640x480px. Wide-field contact fundus photograph of an infant: 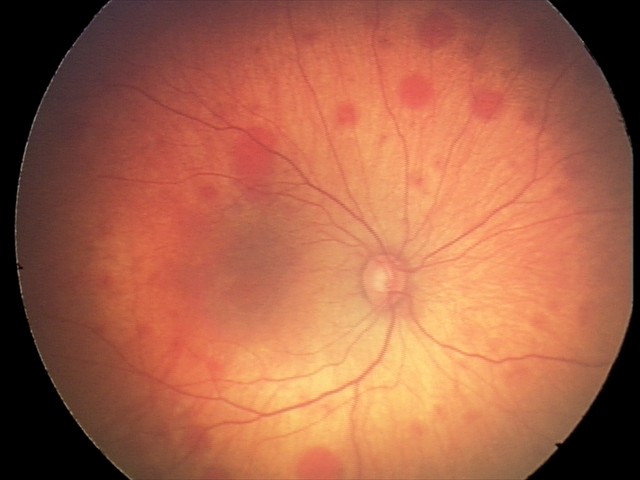

Screening series with retinal hemorrhages.